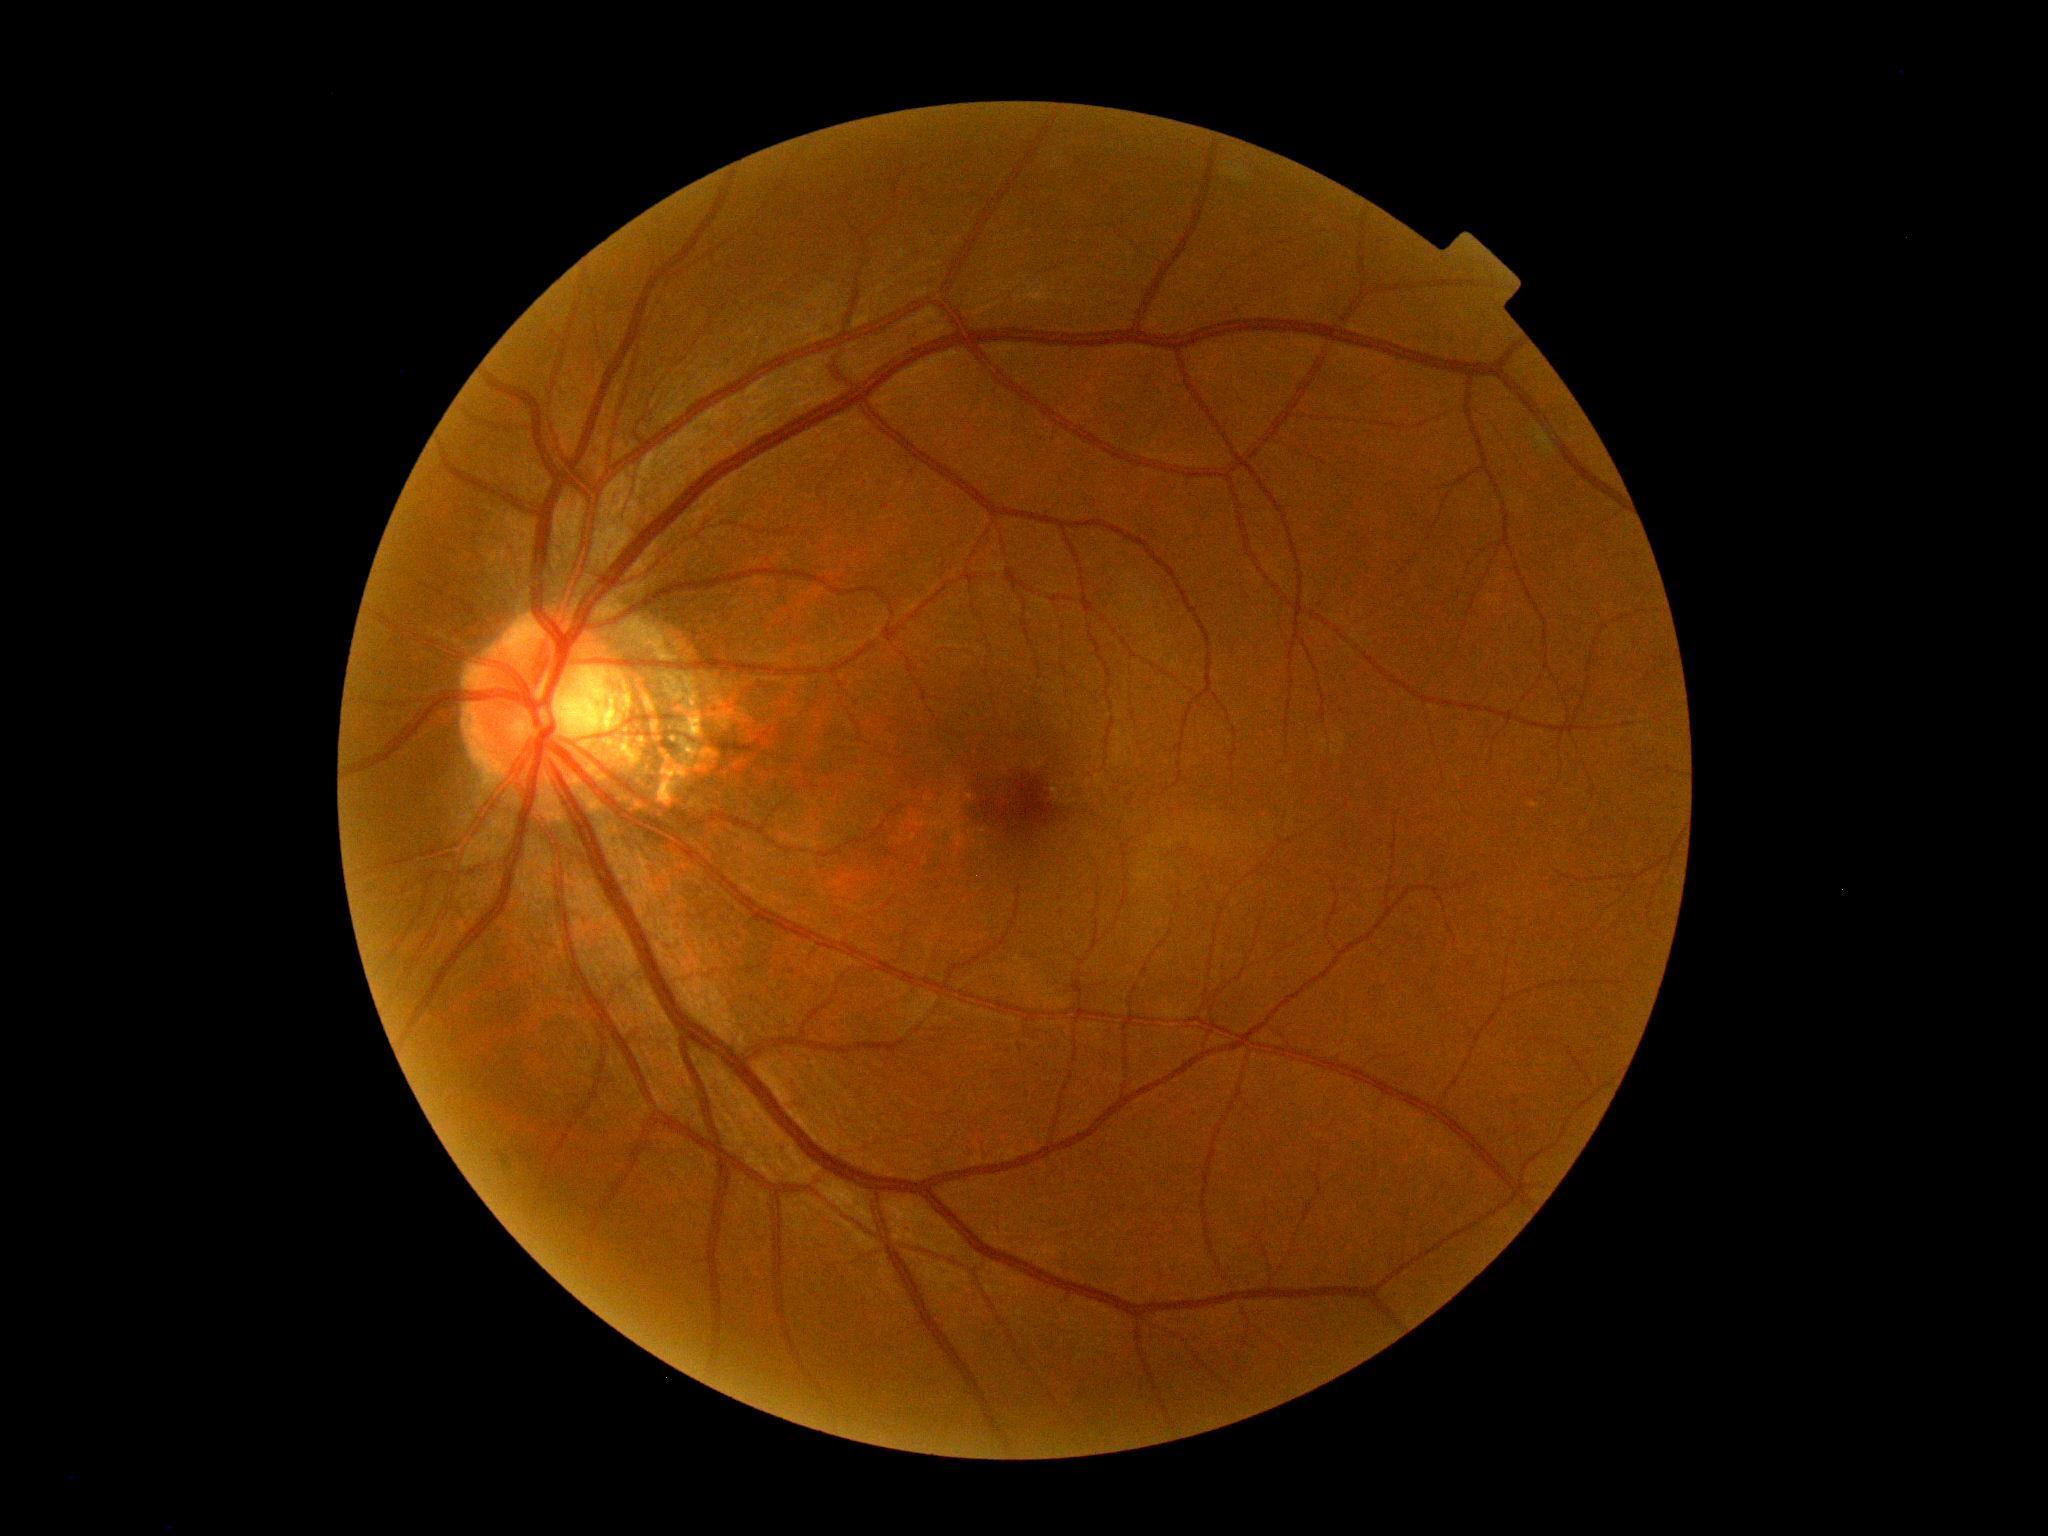
DR=no apparent diabetic retinopathy (grade 0).